2228x1652px:
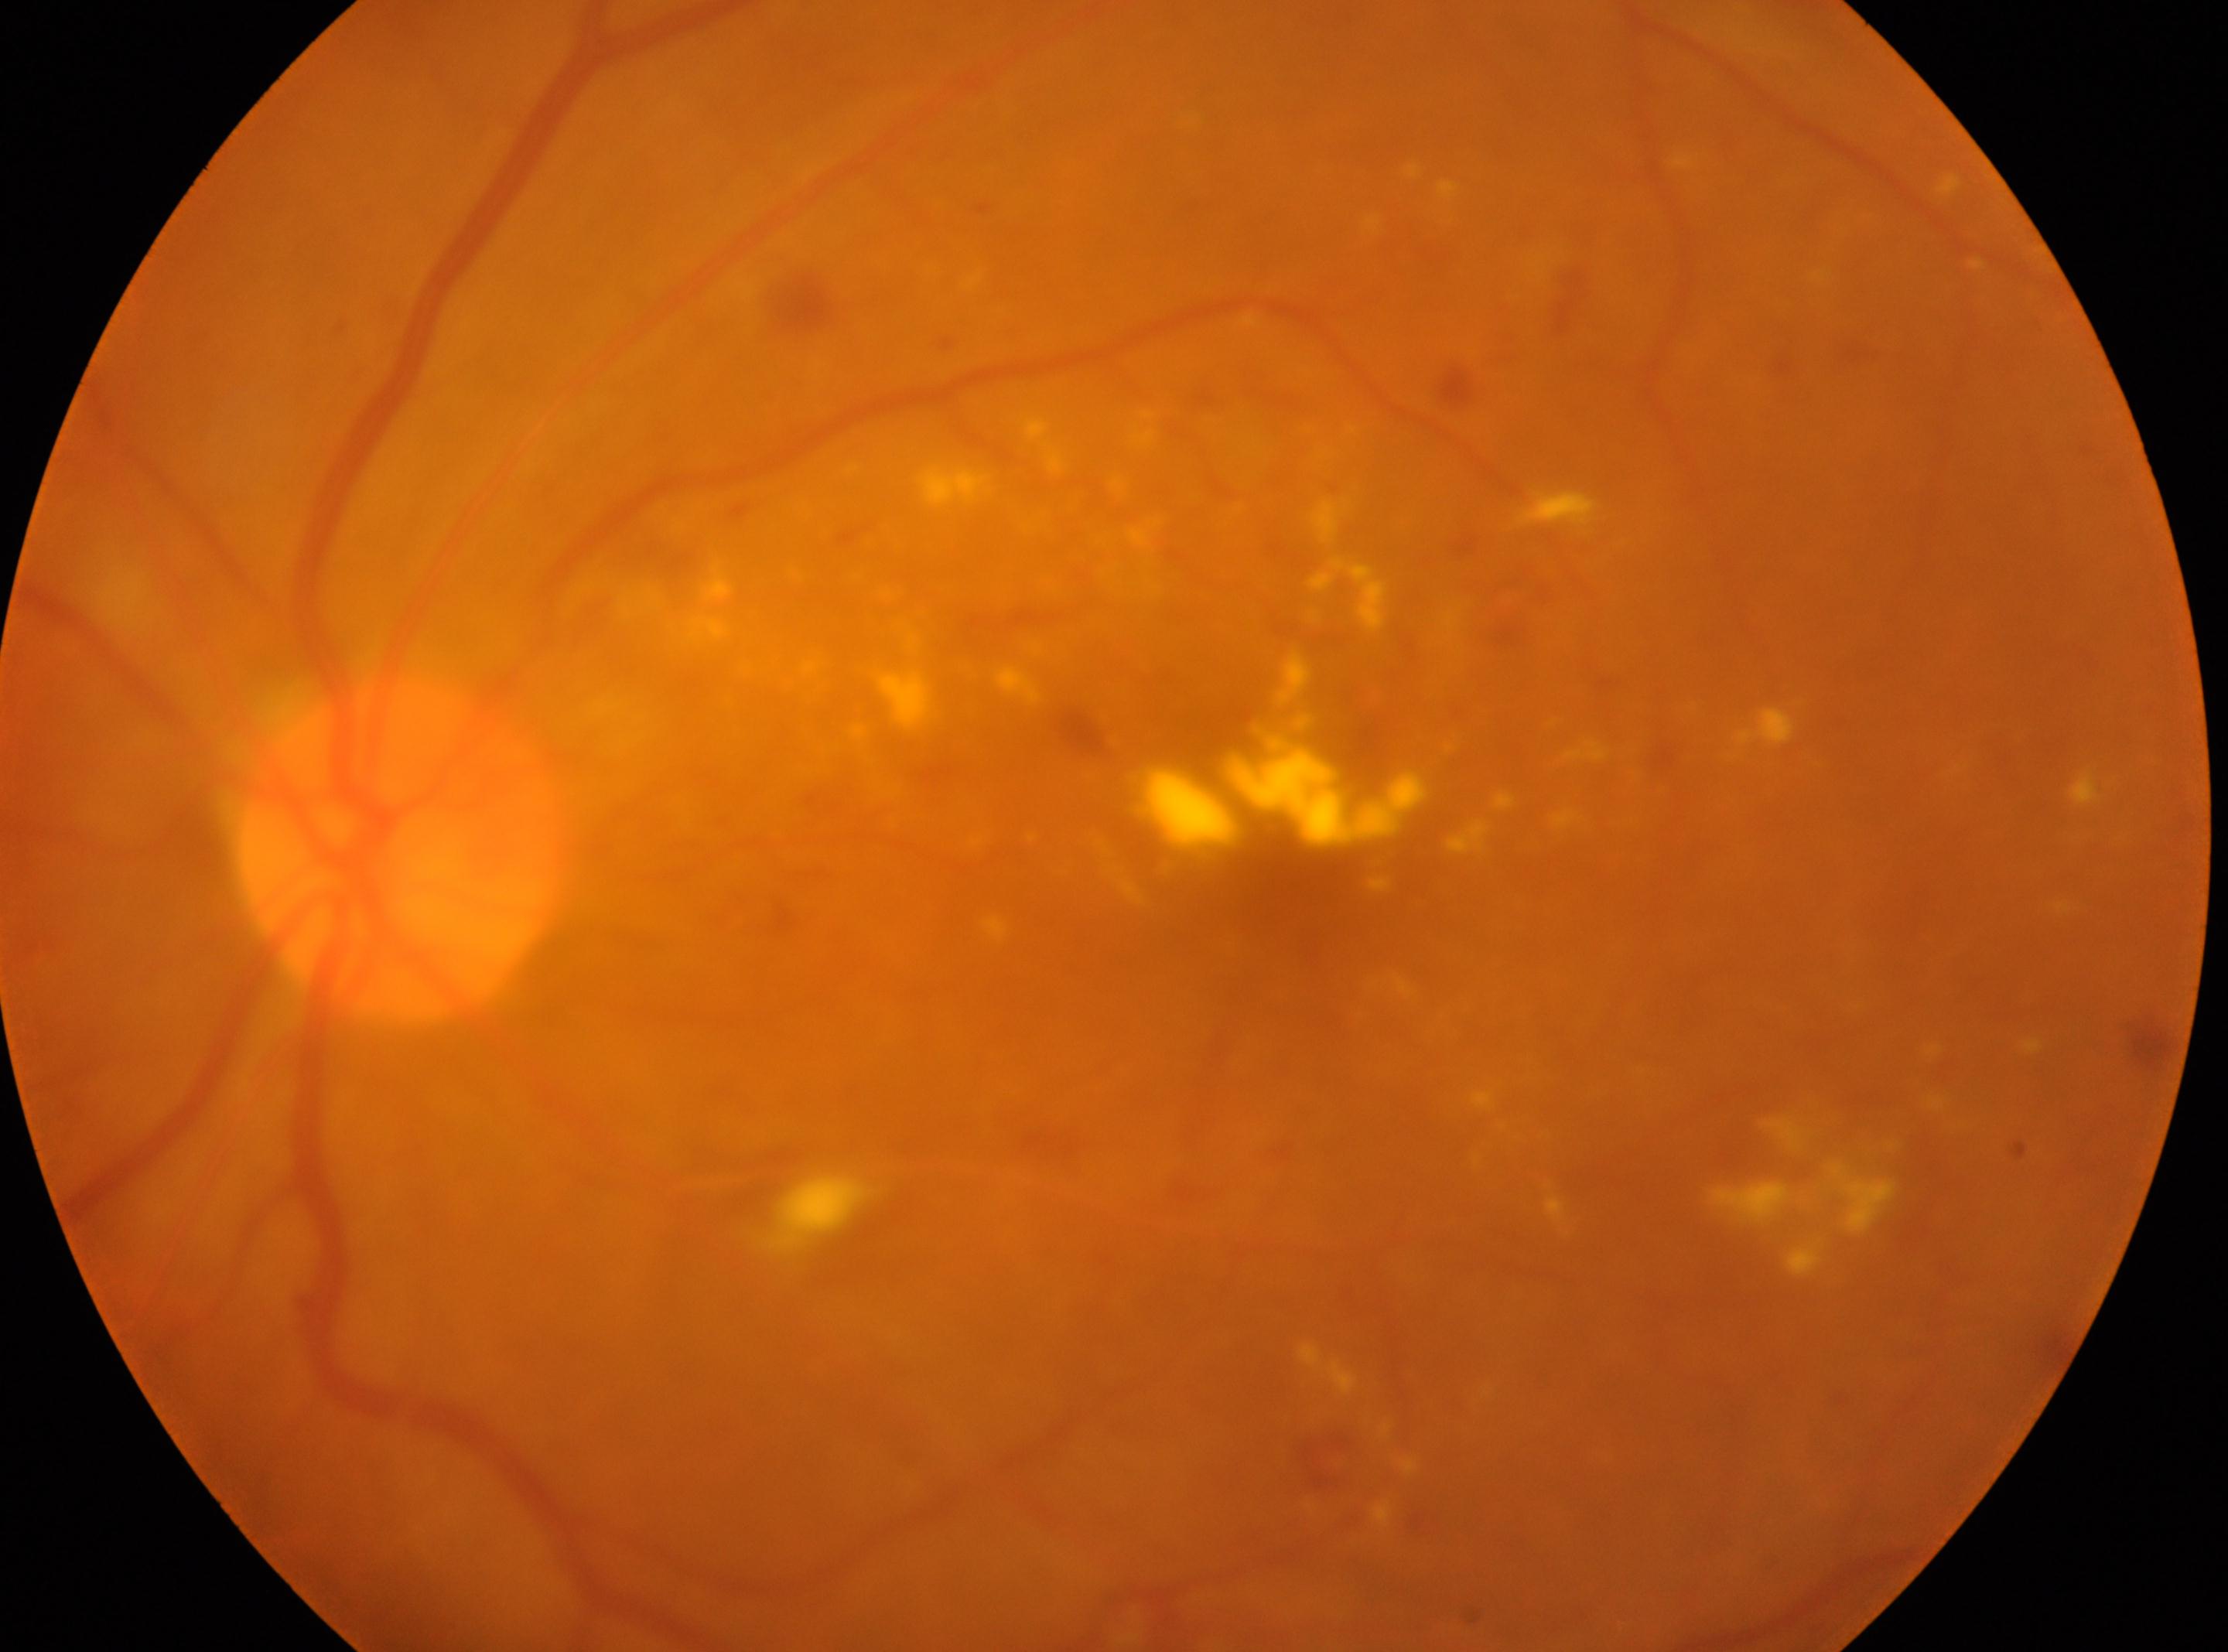
disc center: (399, 846) | laterality: oculus sinister | diabetic retinopathy (DR): moderate NPDR (grade 2) | the fovea: (1286, 880).